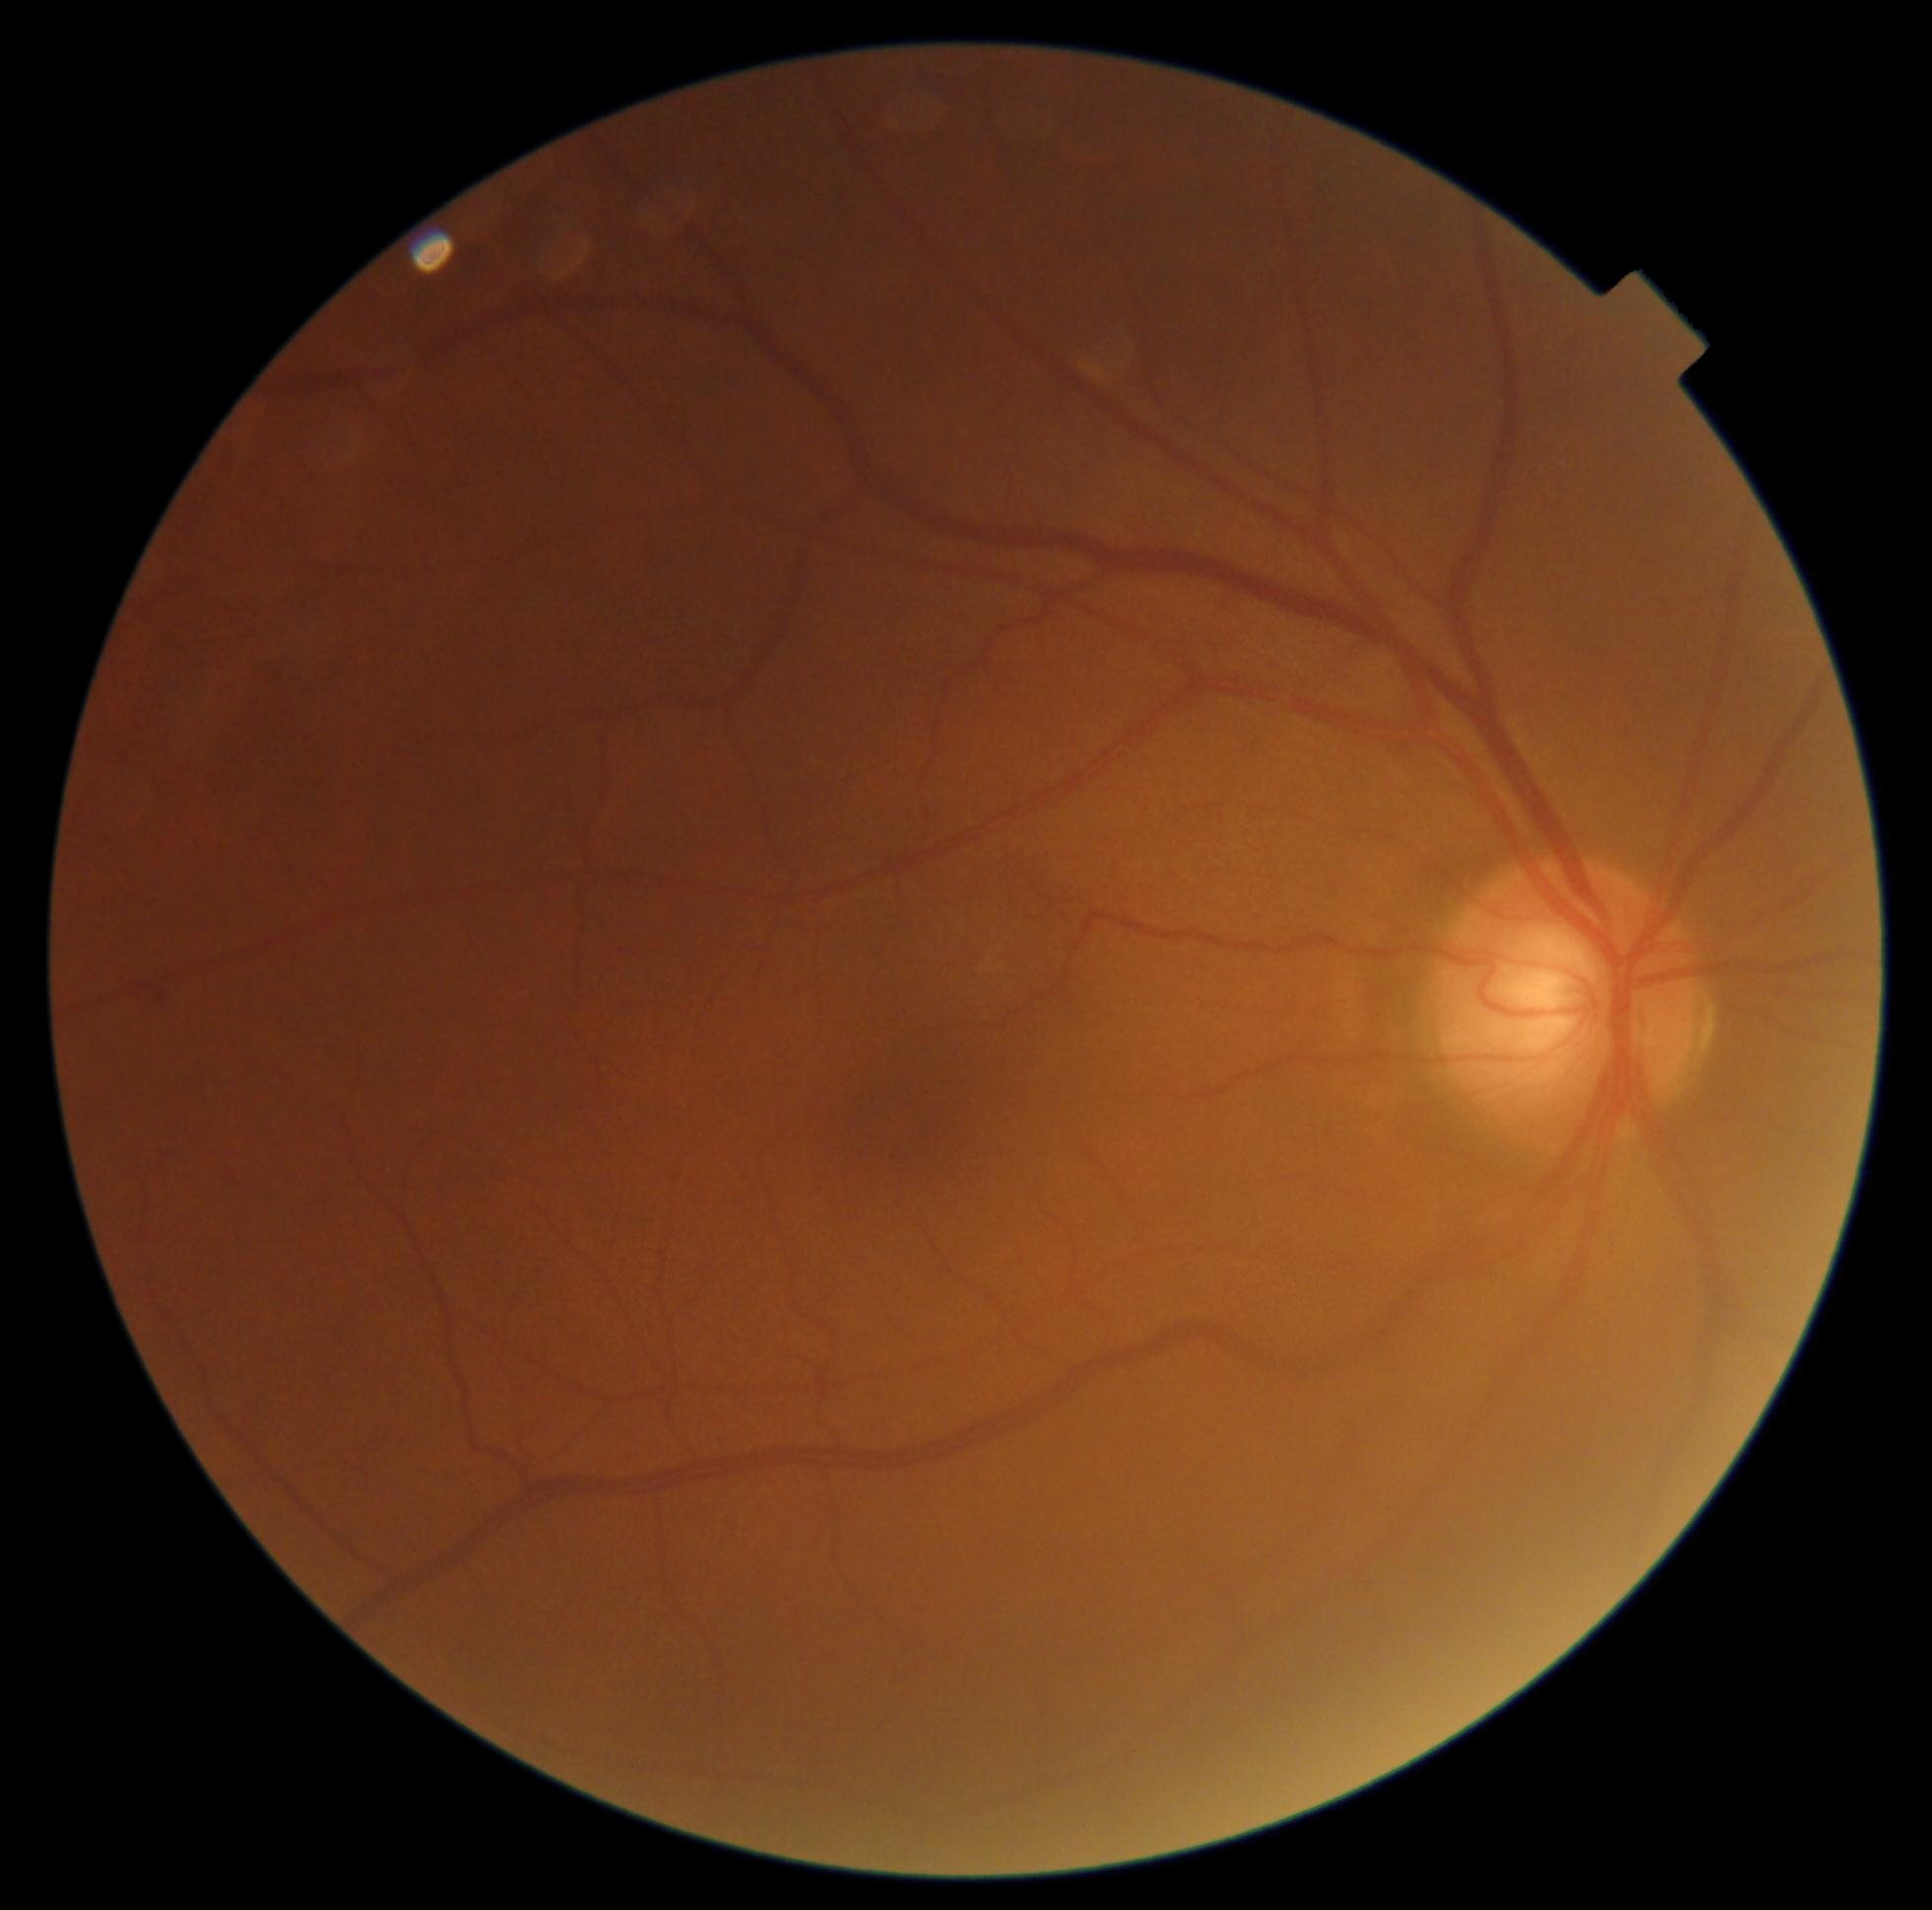
Disease class: non-proliferative diabetic retinopathy.
Diabetic retinopathy: mild non-proliferative diabetic retinopathy (grade 1).